NIDEK AFC-230 — 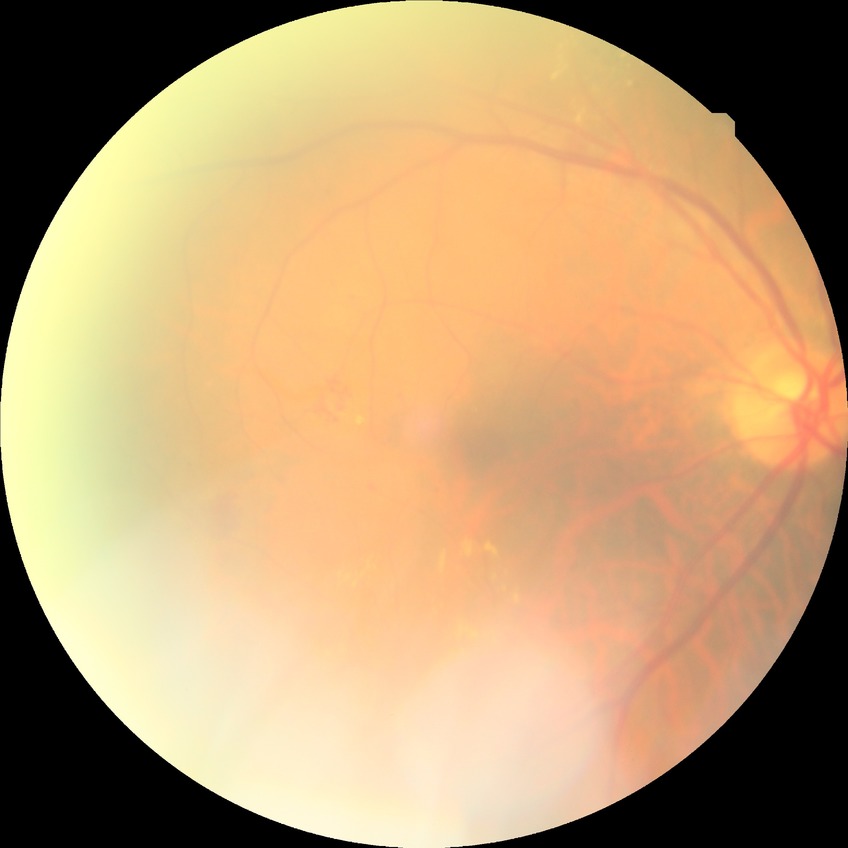
DR class: non-proliferative diabetic retinopathy. Diabetic retinopathy (DR) is simple diabetic retinopathy (SDR).